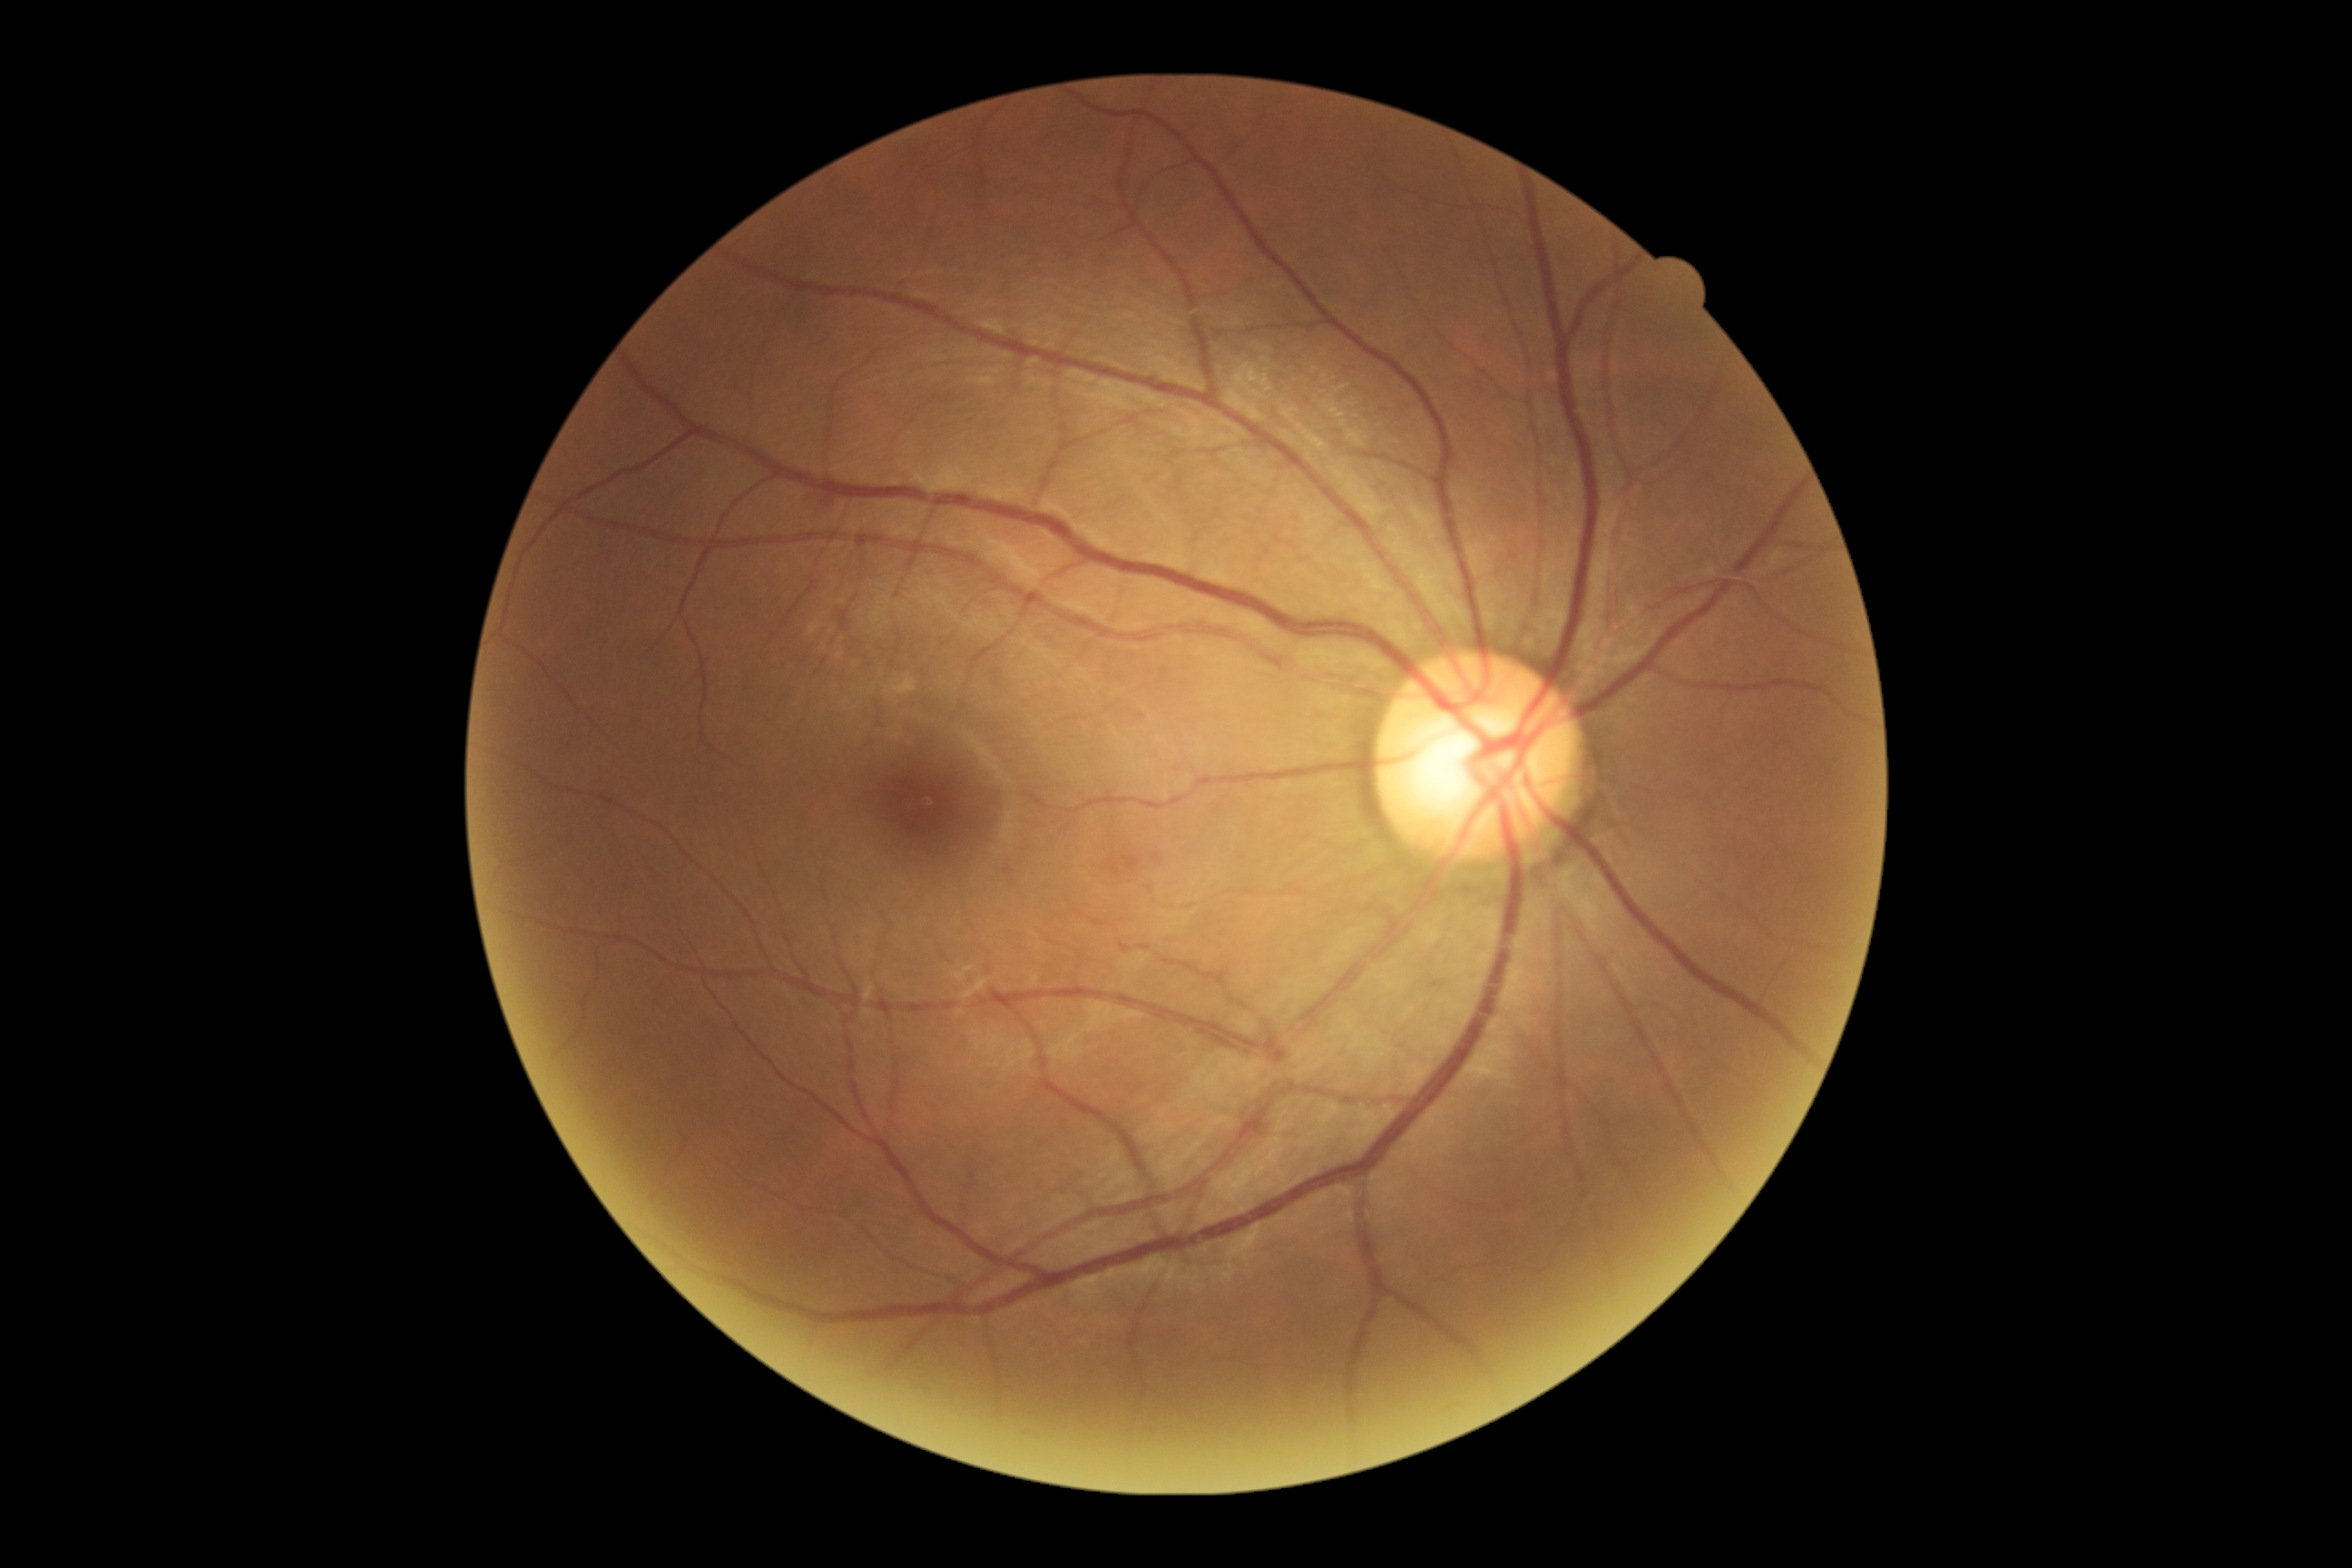
Retinopathy grade is 0 (no apparent retinopathy).